Retinal fundus photograph · 2212x1659px · 45° field of view: 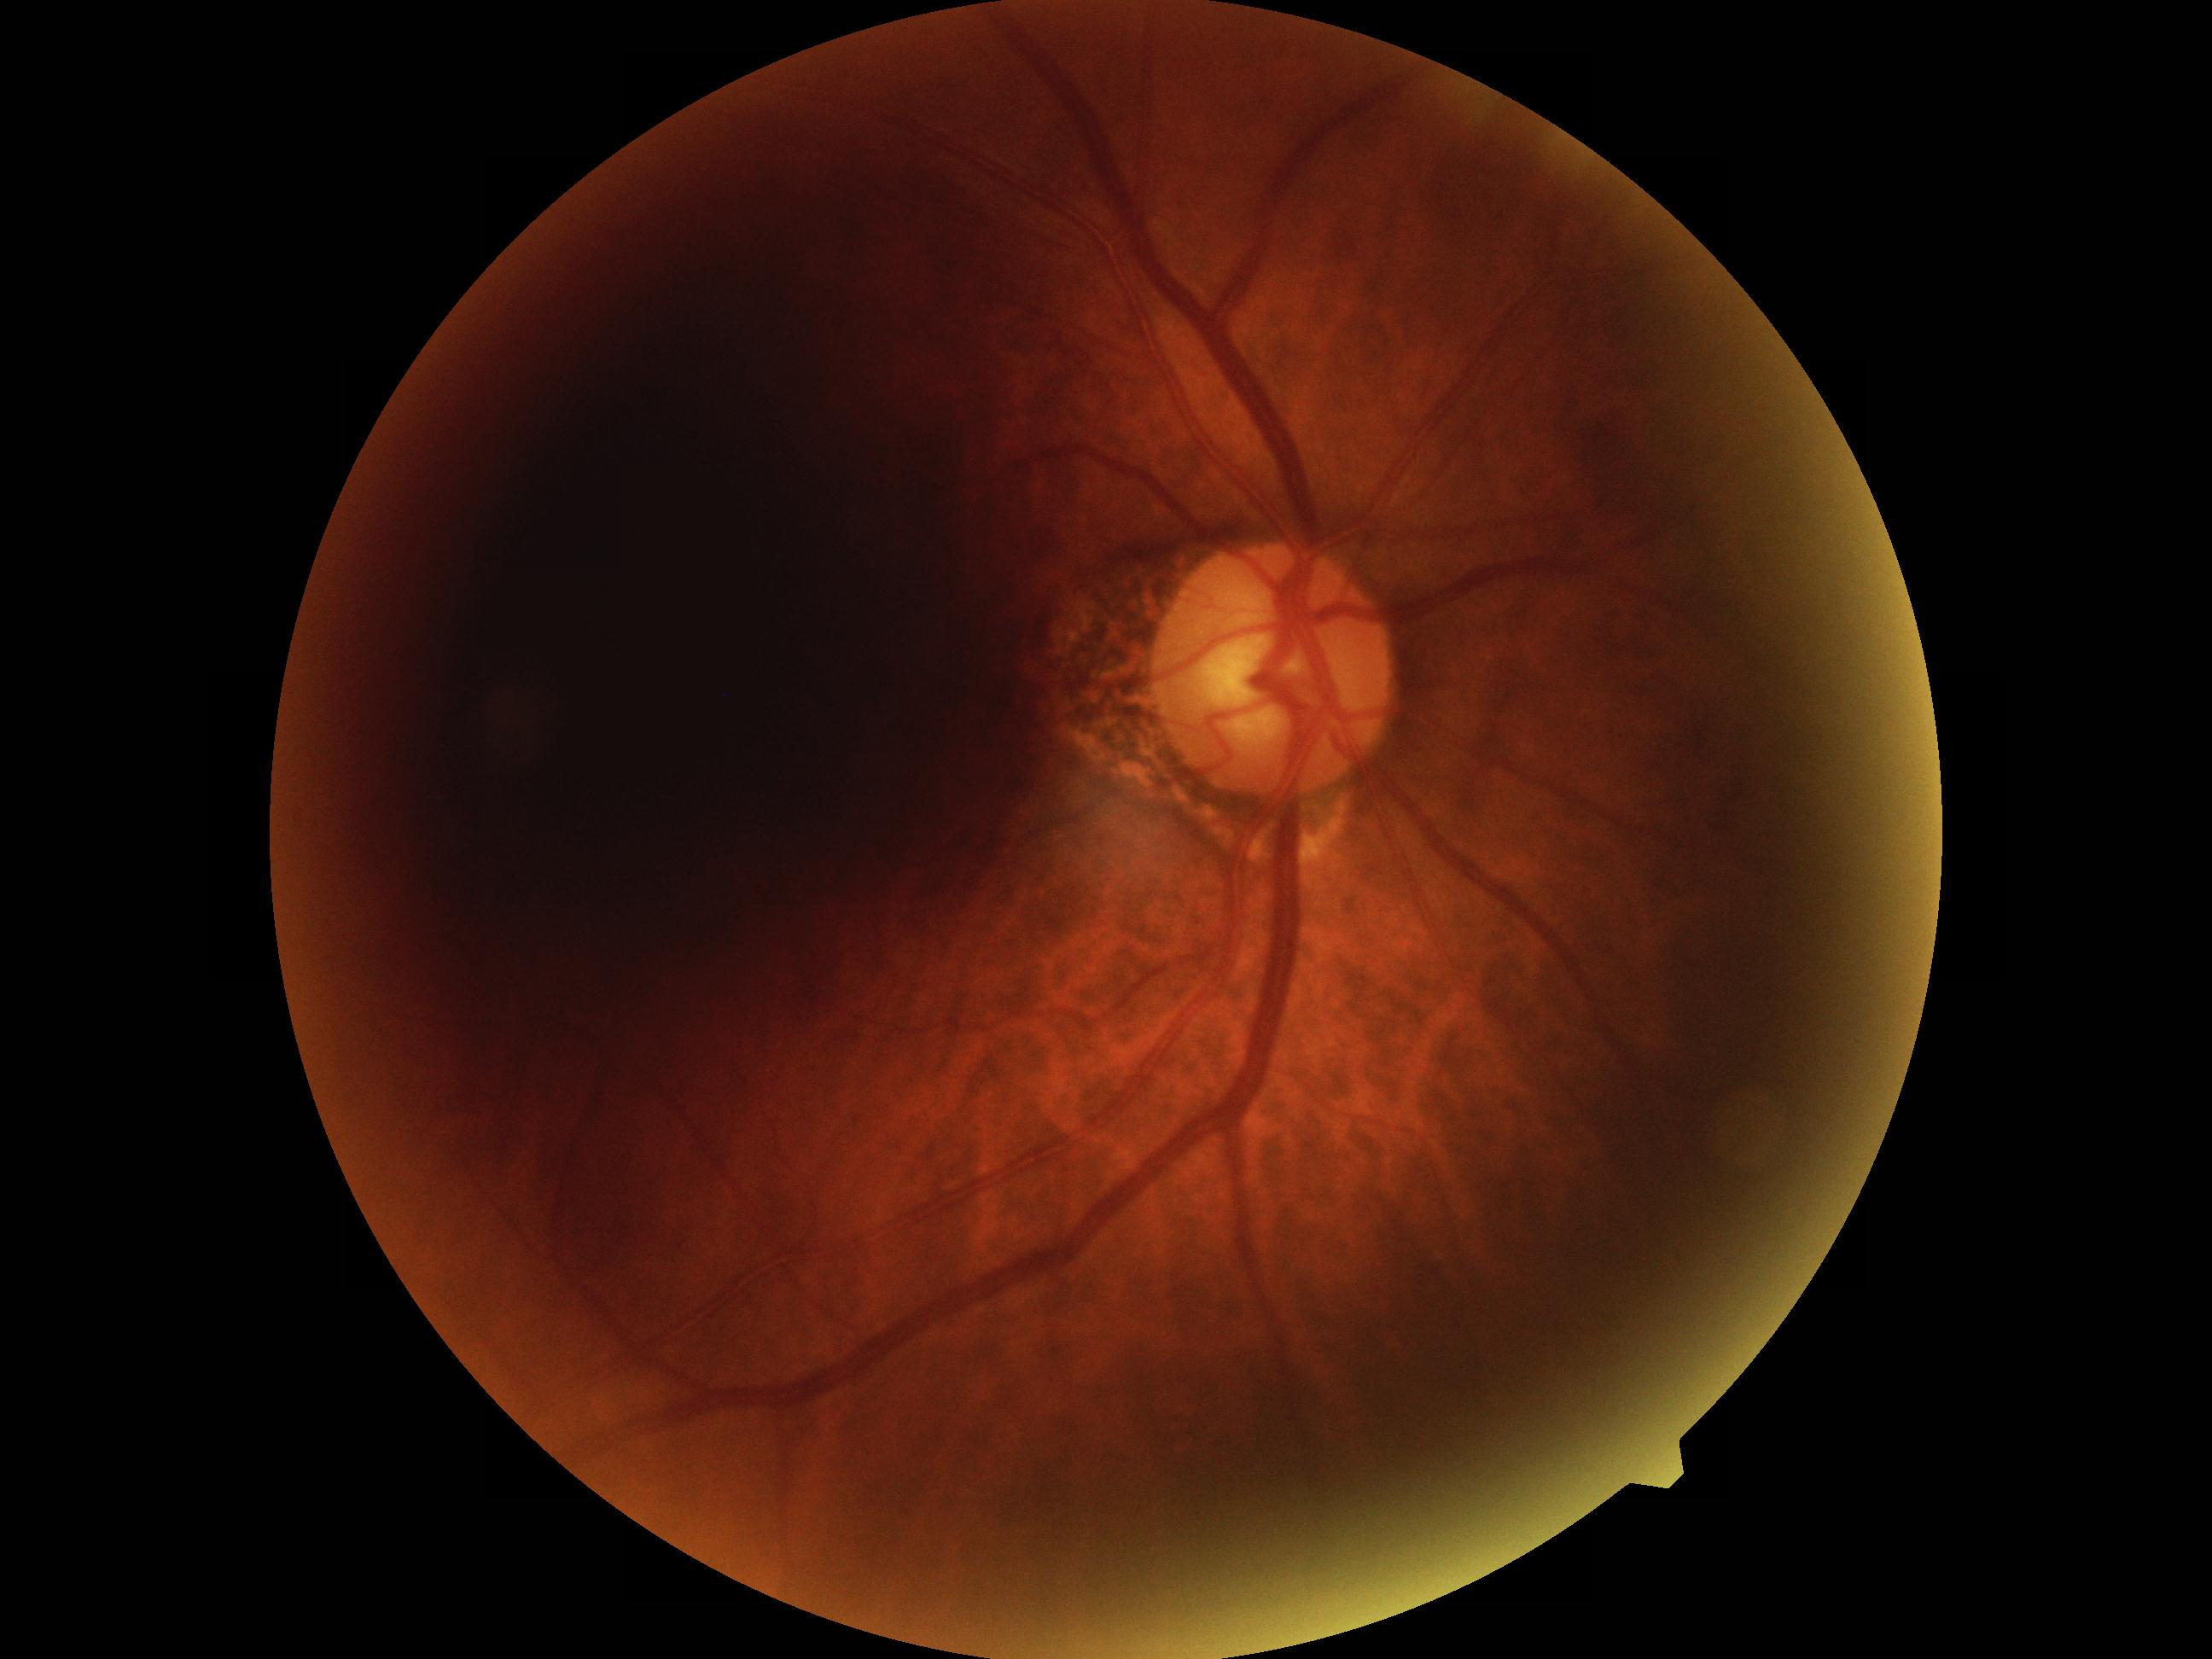

{"dr_grade": "no apparent retinopathy (0) — no visible signs of diabetic retinopathy"}